Pediatric retinal photograph (wide-field); image size 640x480 — 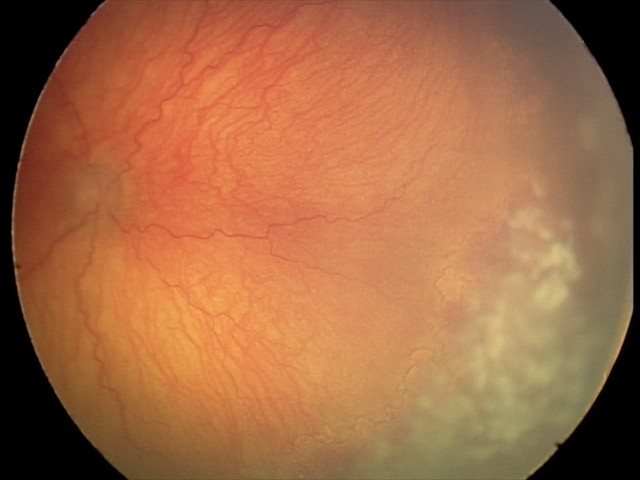 Q: What is the plus-form classification?
A: plus disease — abnormal dilation and tortuosity of the posterior pole retinal vessels
Q: What is the diagnosis from this examination?
A: A-ROP (aggressive ROP)